Mydriatic (tropicamide and phenylephrine); field includes the optic disc and macula; FOV: 50 degrees; 2228x1652px; captured on a Topcon TRC-50DX fundus camera:
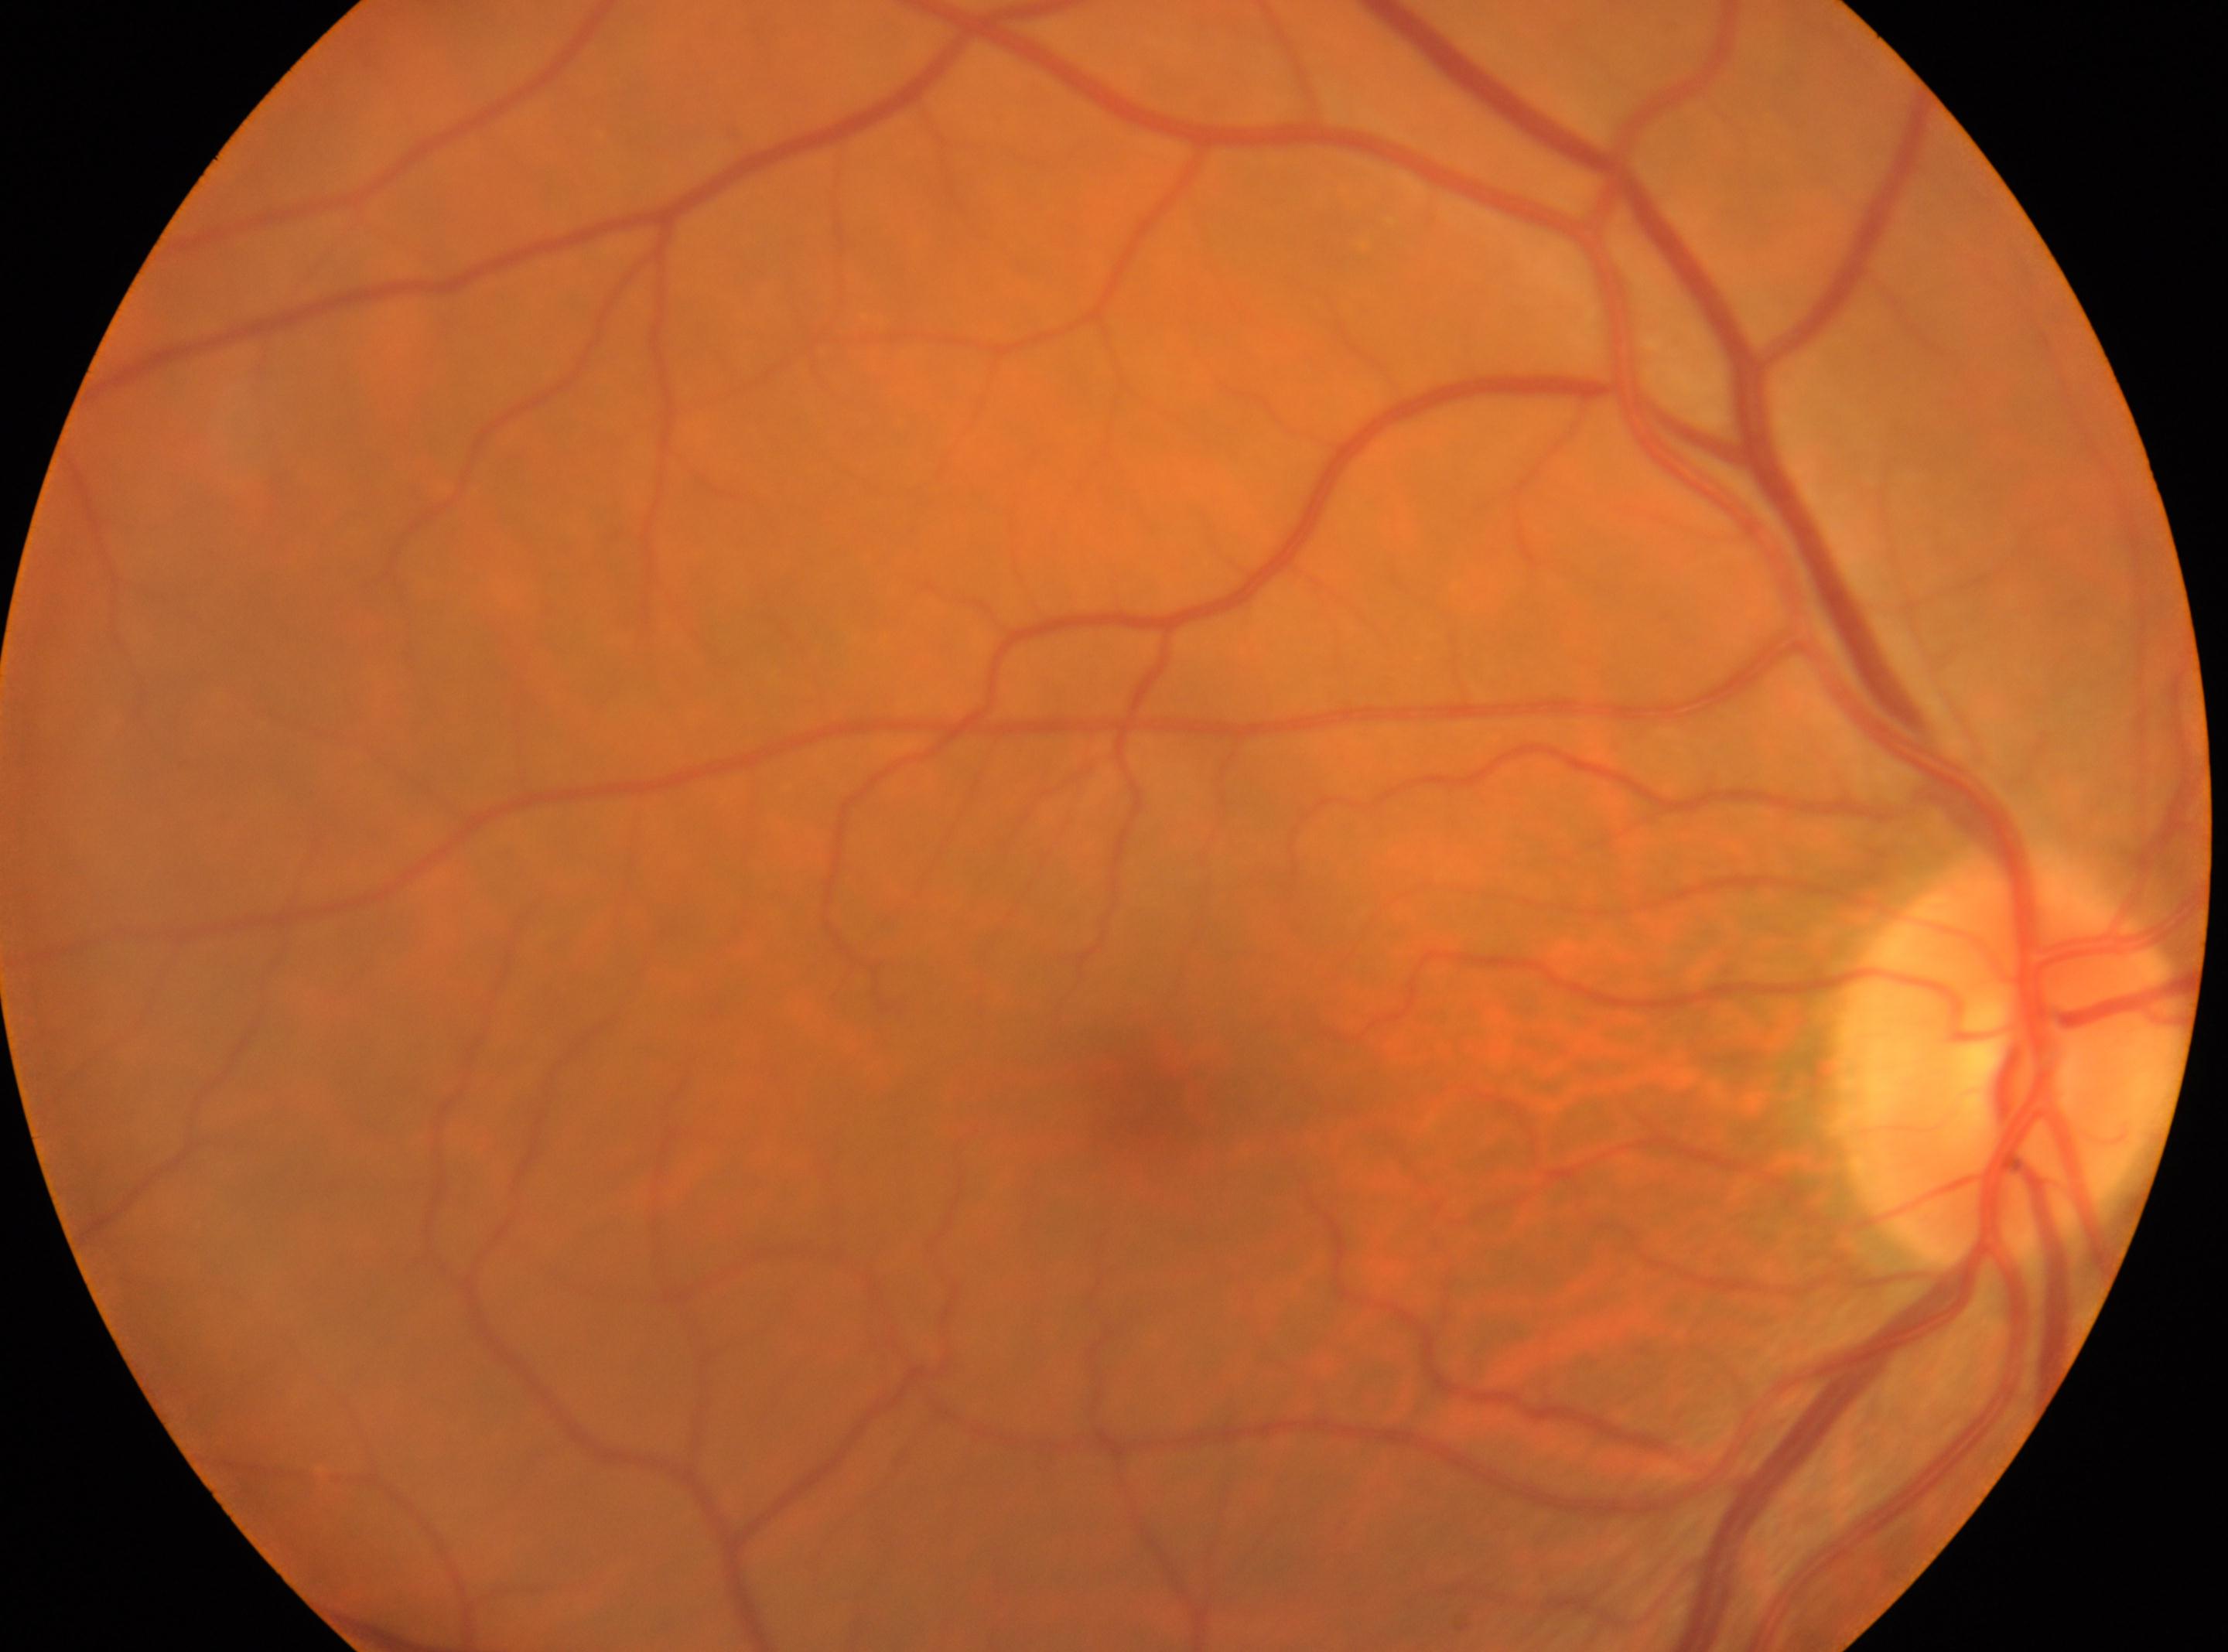
macular center: 1146, 1087 | retinopathy: grade 0 | optic disk: 2010, 1066 | DR impression: No signs of diabetic retinopathy | laterality: right.